1240x1240px; wide-field fundus photograph of an infant
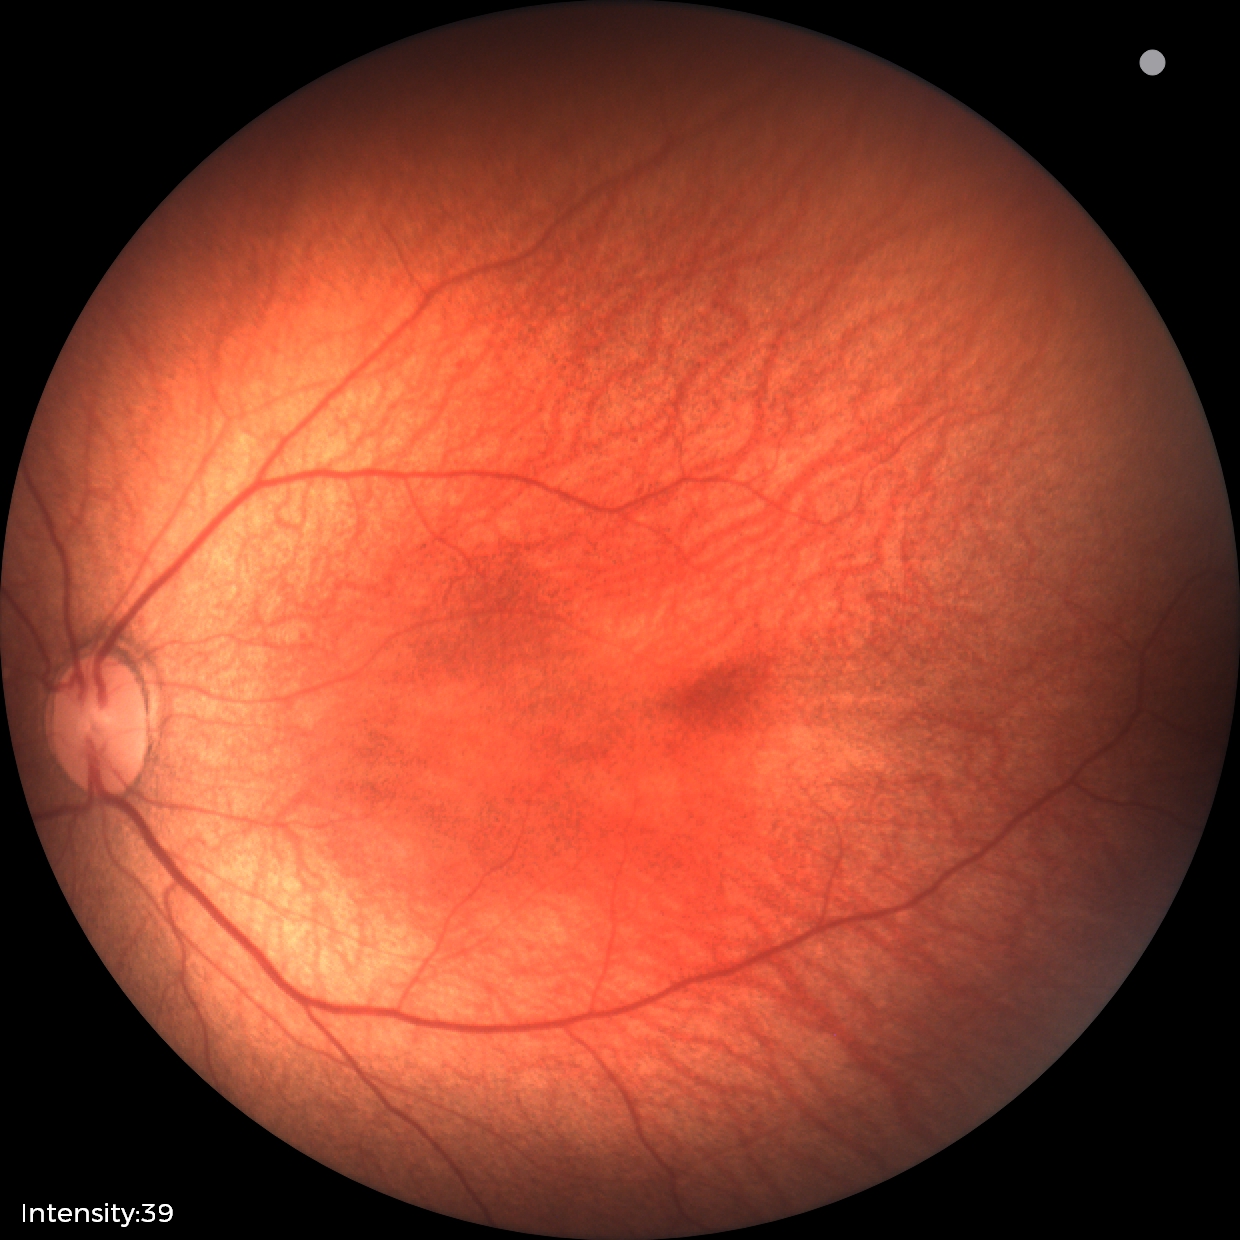

Examination diagnosed as status post ROP. Without plus disease.